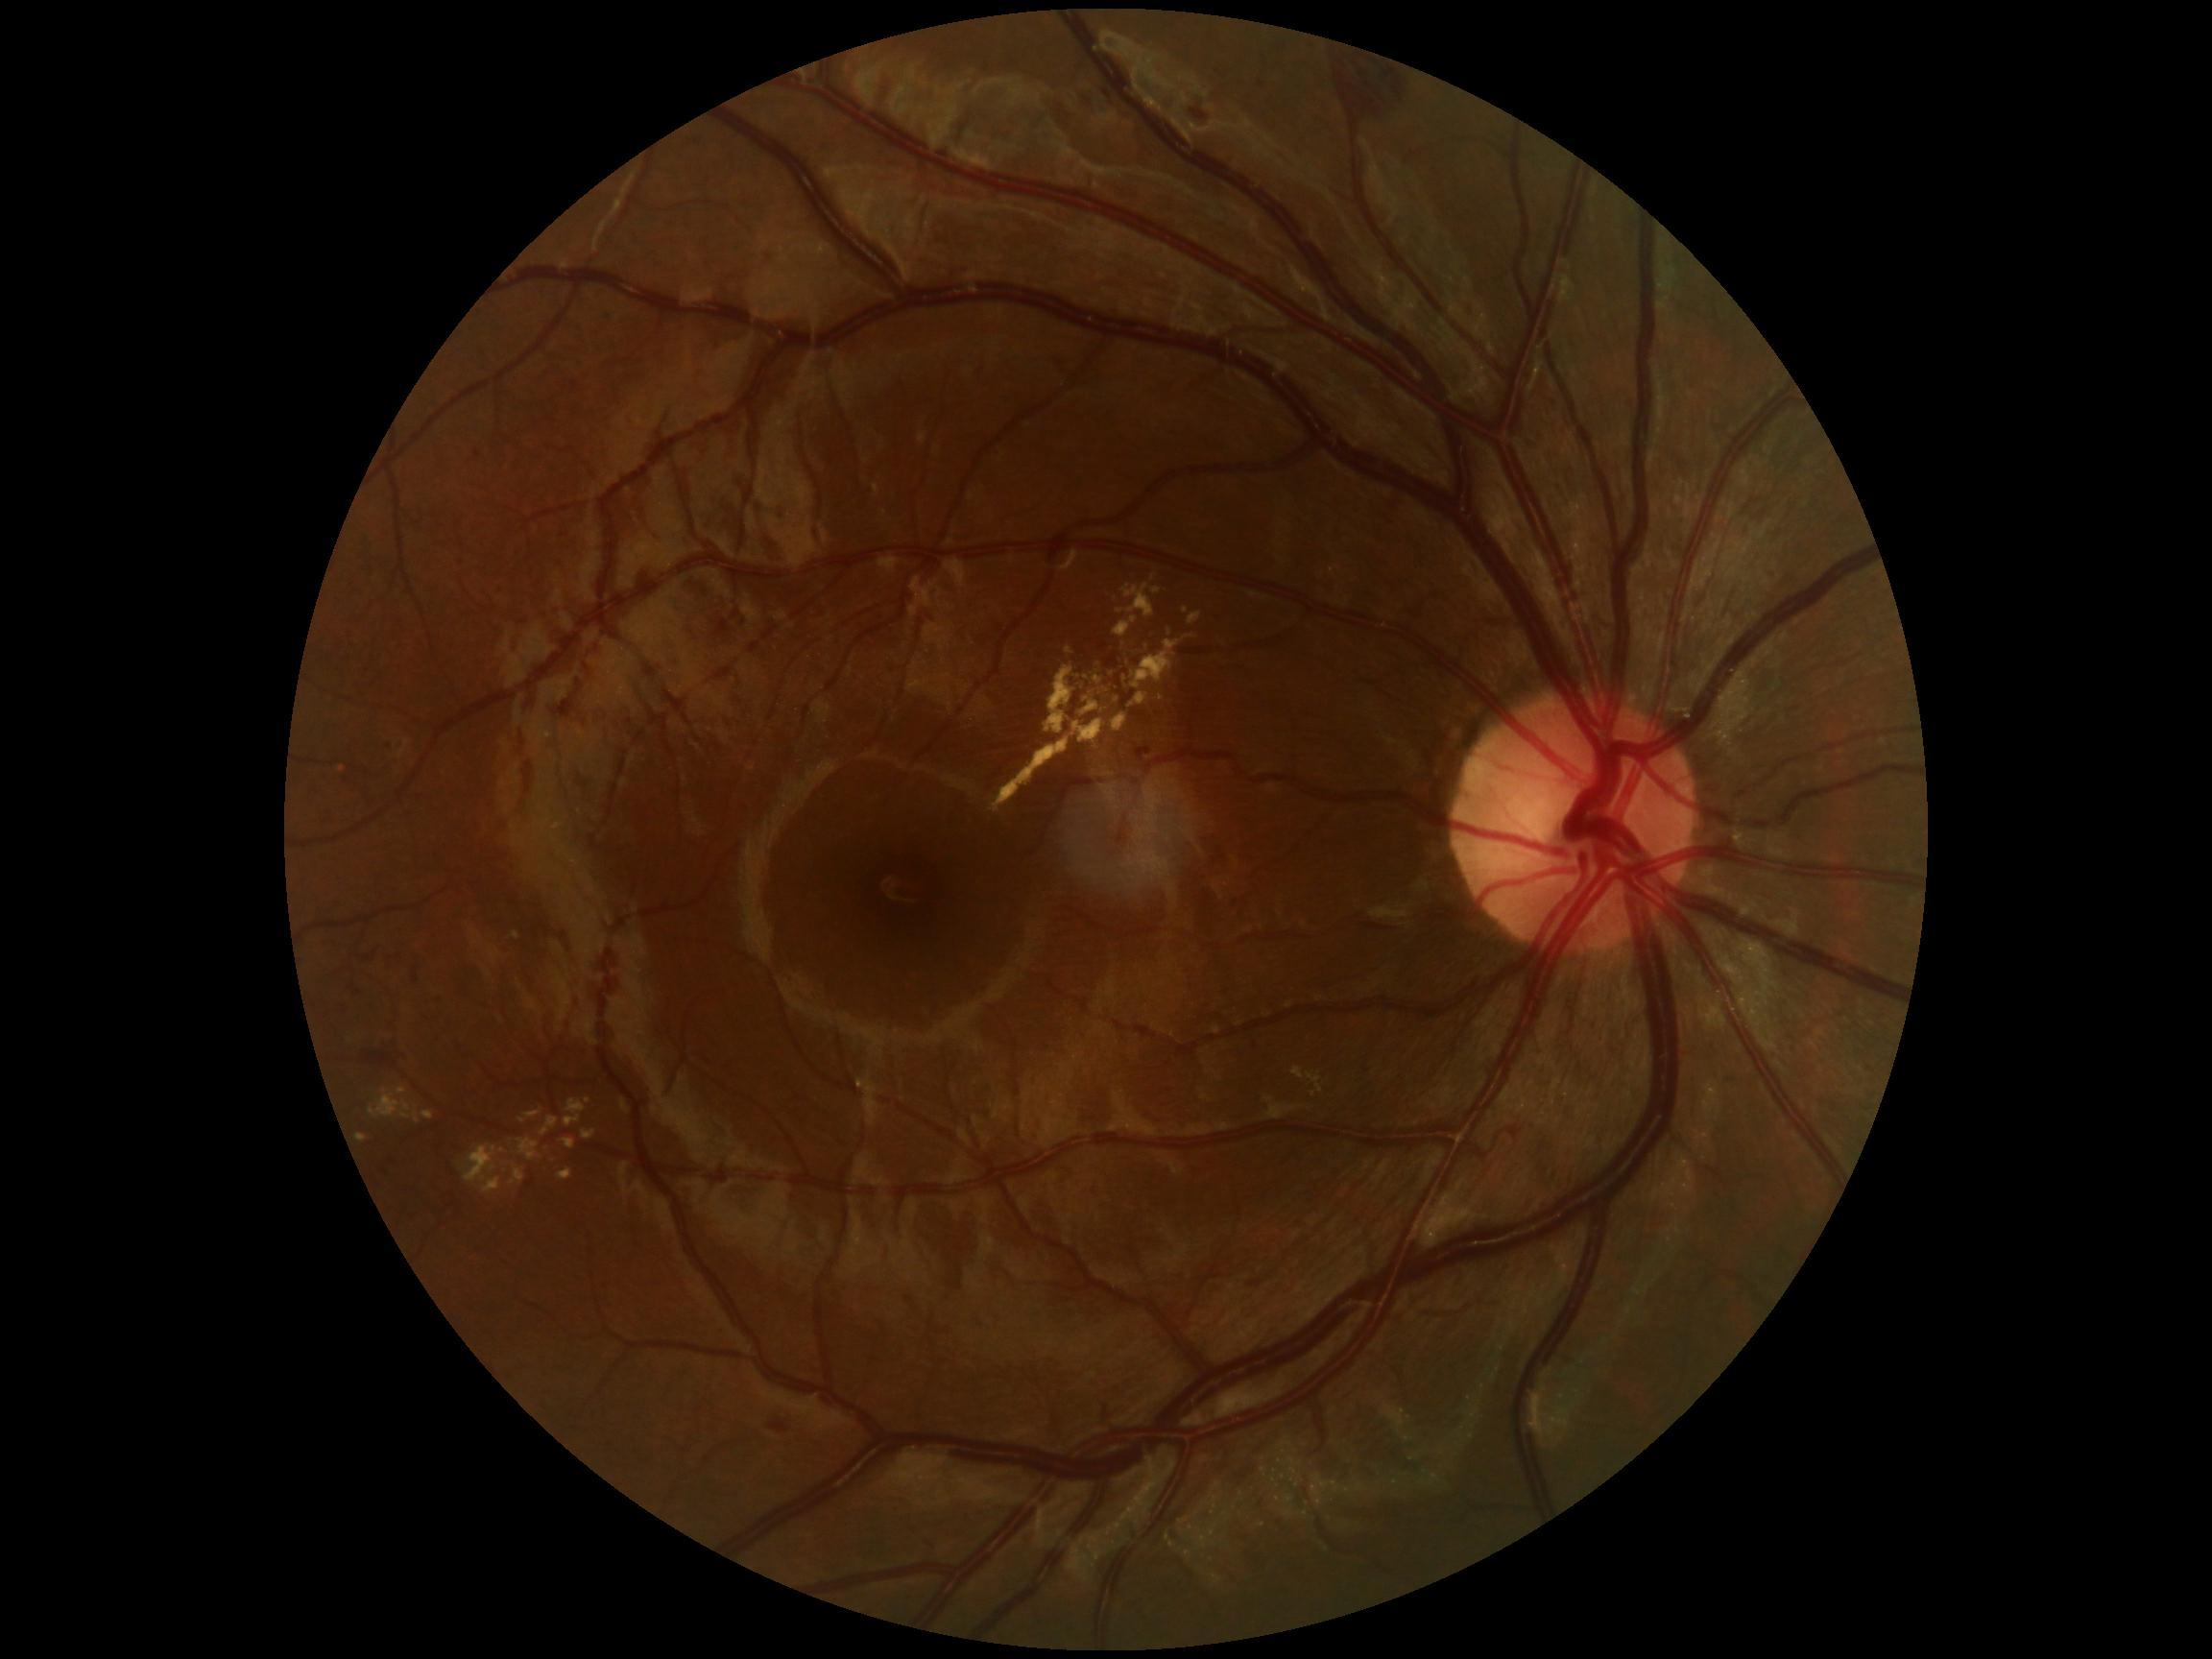

Diabetic retinopathy (DR) is moderate non-proliferative diabetic retinopathy (grade 2).
Hard exudates (EXs) are present, including at 1152, 589, 1162, 595 | 565, 1099, 586, 1128 | 1132, 641, 1181, 689 | 369, 1090, 421, 1125 | 541, 1117, 560, 1138 | 563, 1140, 576, 1150 | 519, 1111, 542, 1125 | 1190, 613, 1202, 625 | 1130, 693, 1149, 708 | 397, 1088, 407, 1096.
EXs (small, approximate centers) near 1069/651 | 506/1171 | 1099/662 | 1114/672 | 341/769.